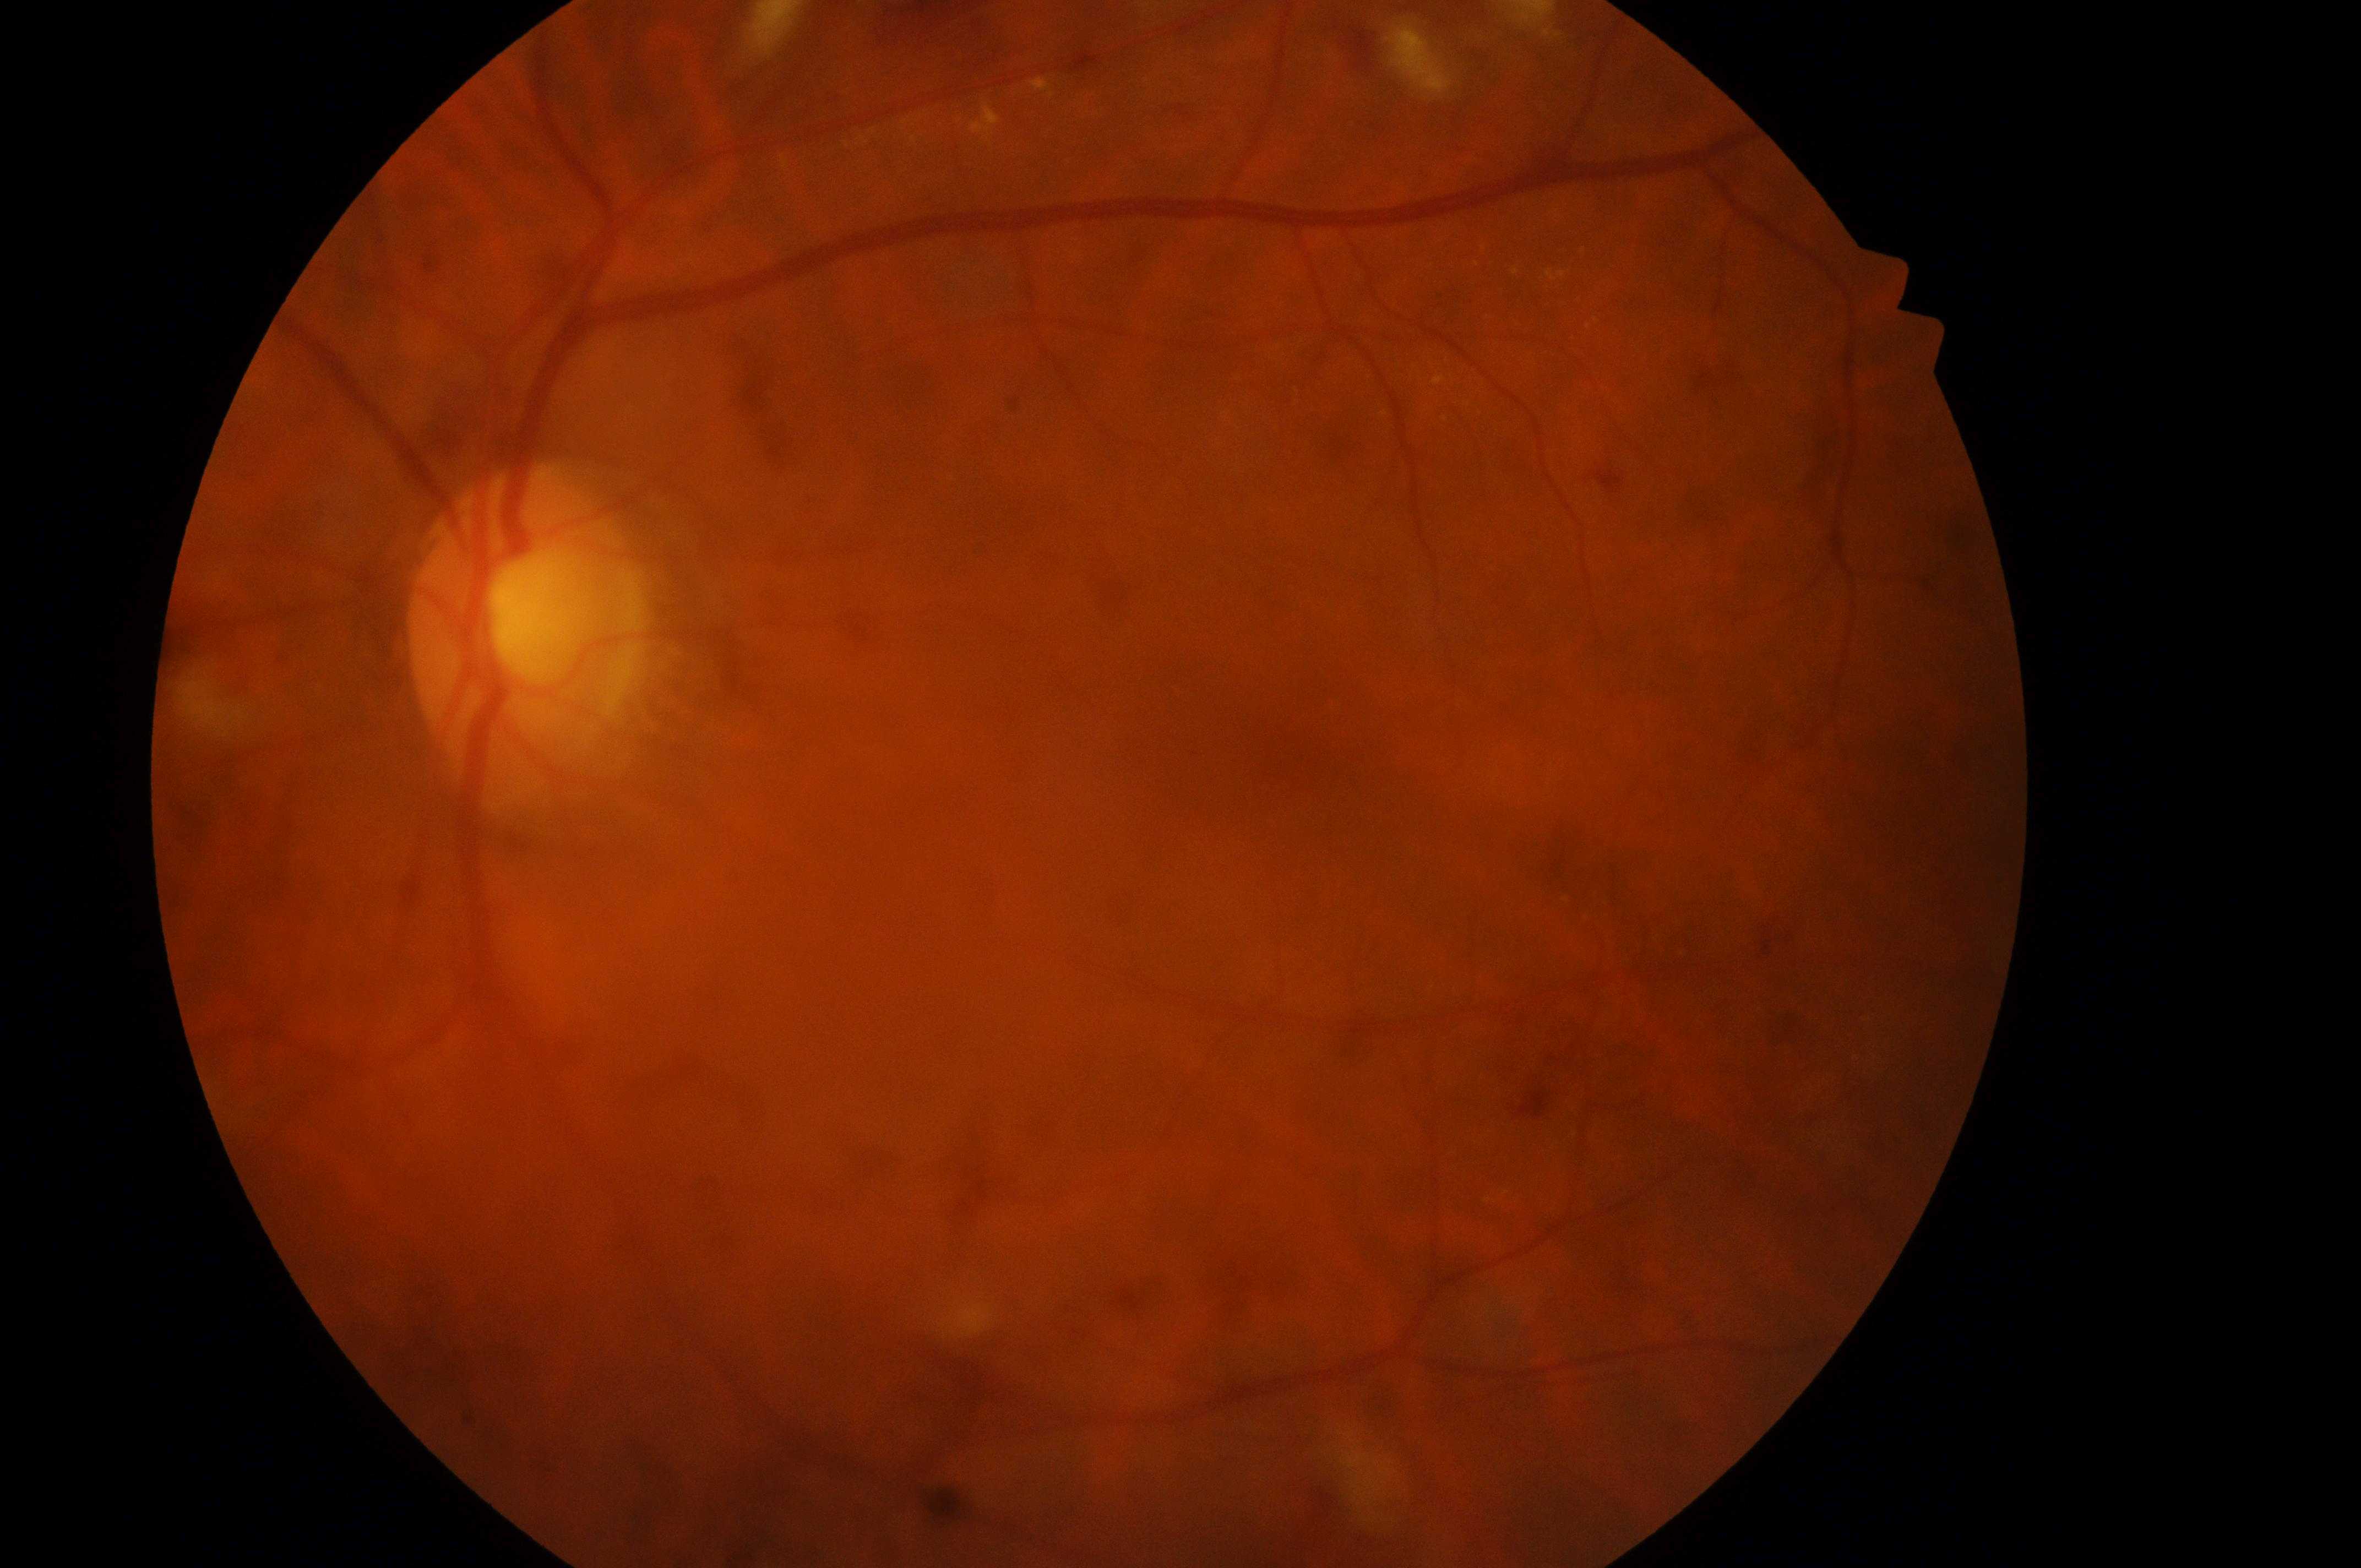
optic_disc: (x=521, y=635)
eye: the left eye
dr_grade: 3/4
fovea: (x=1205, y=734)
dme_grade: 1/2